NIDEK AFC-230 fundus camera: 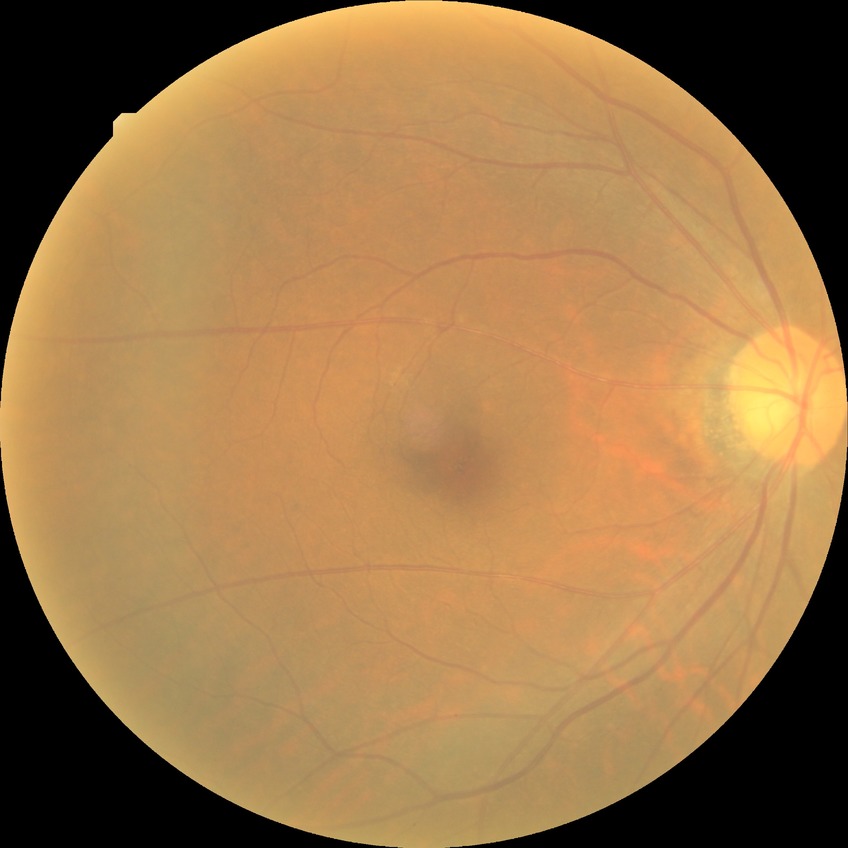 Diabetic retinopathy grade is no diabetic retinopathy.